Color fundus photograph. 2352x1568px — 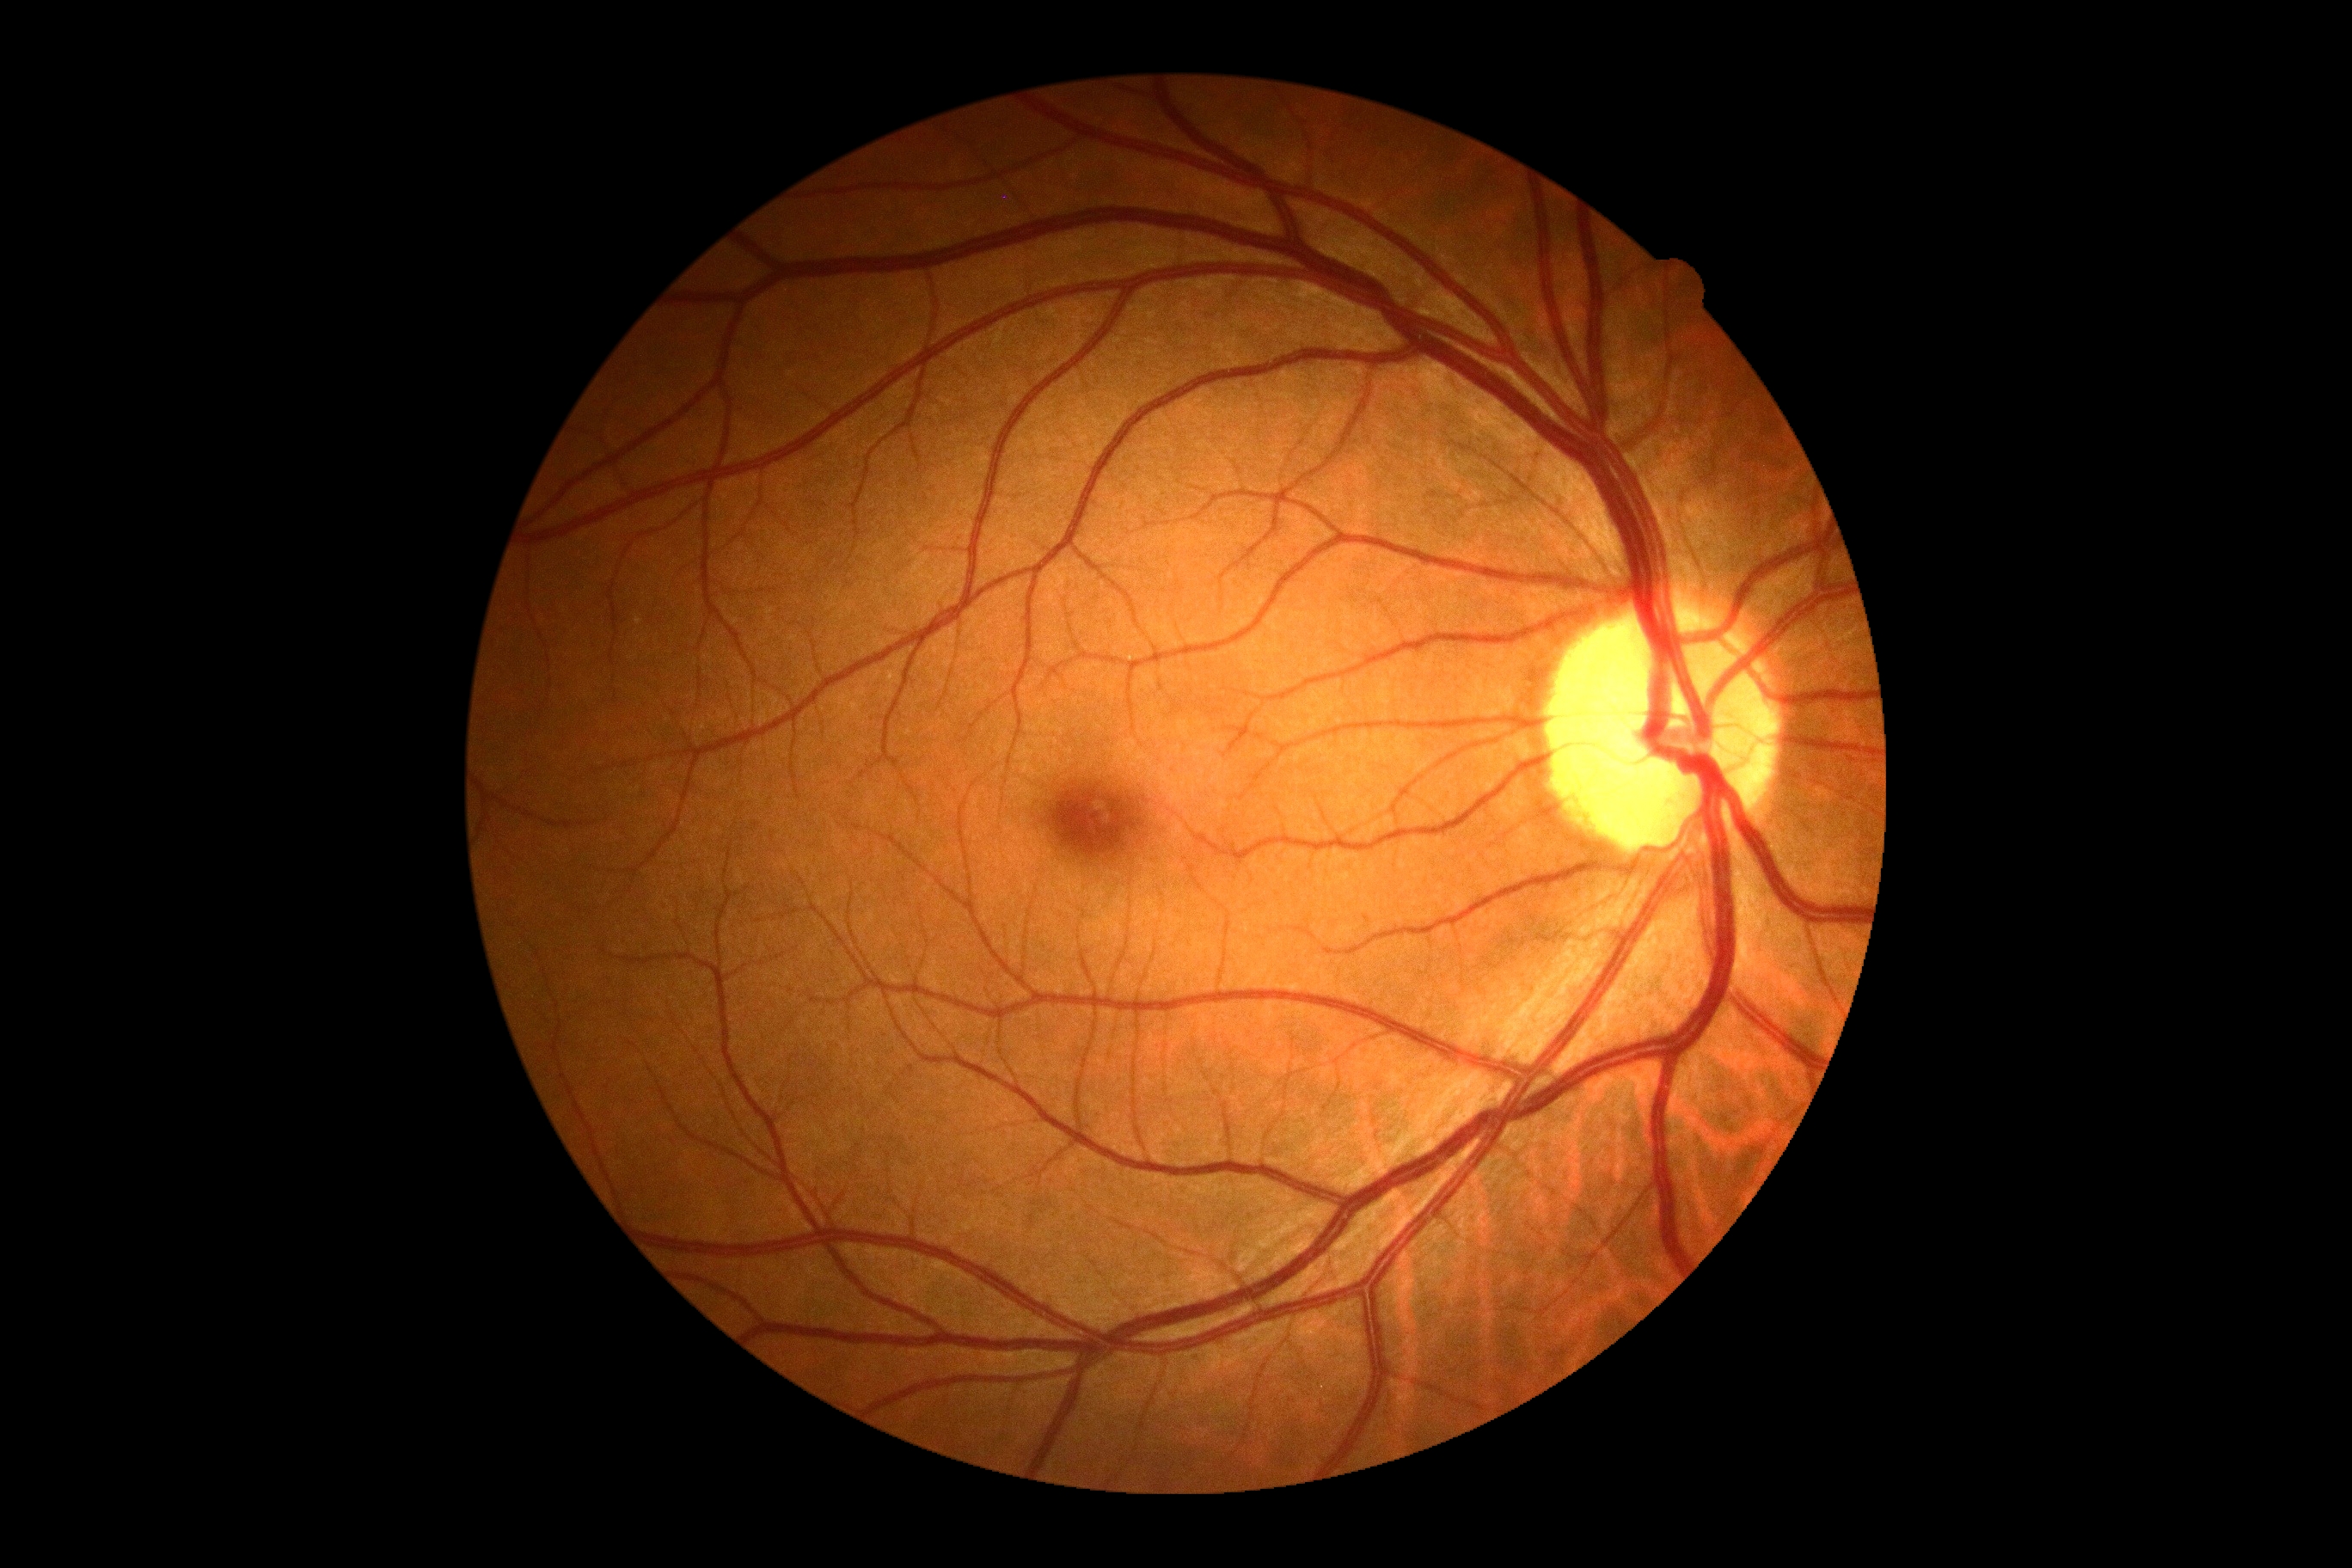
DR impression: no signs of DR, DR stage: 0/4.